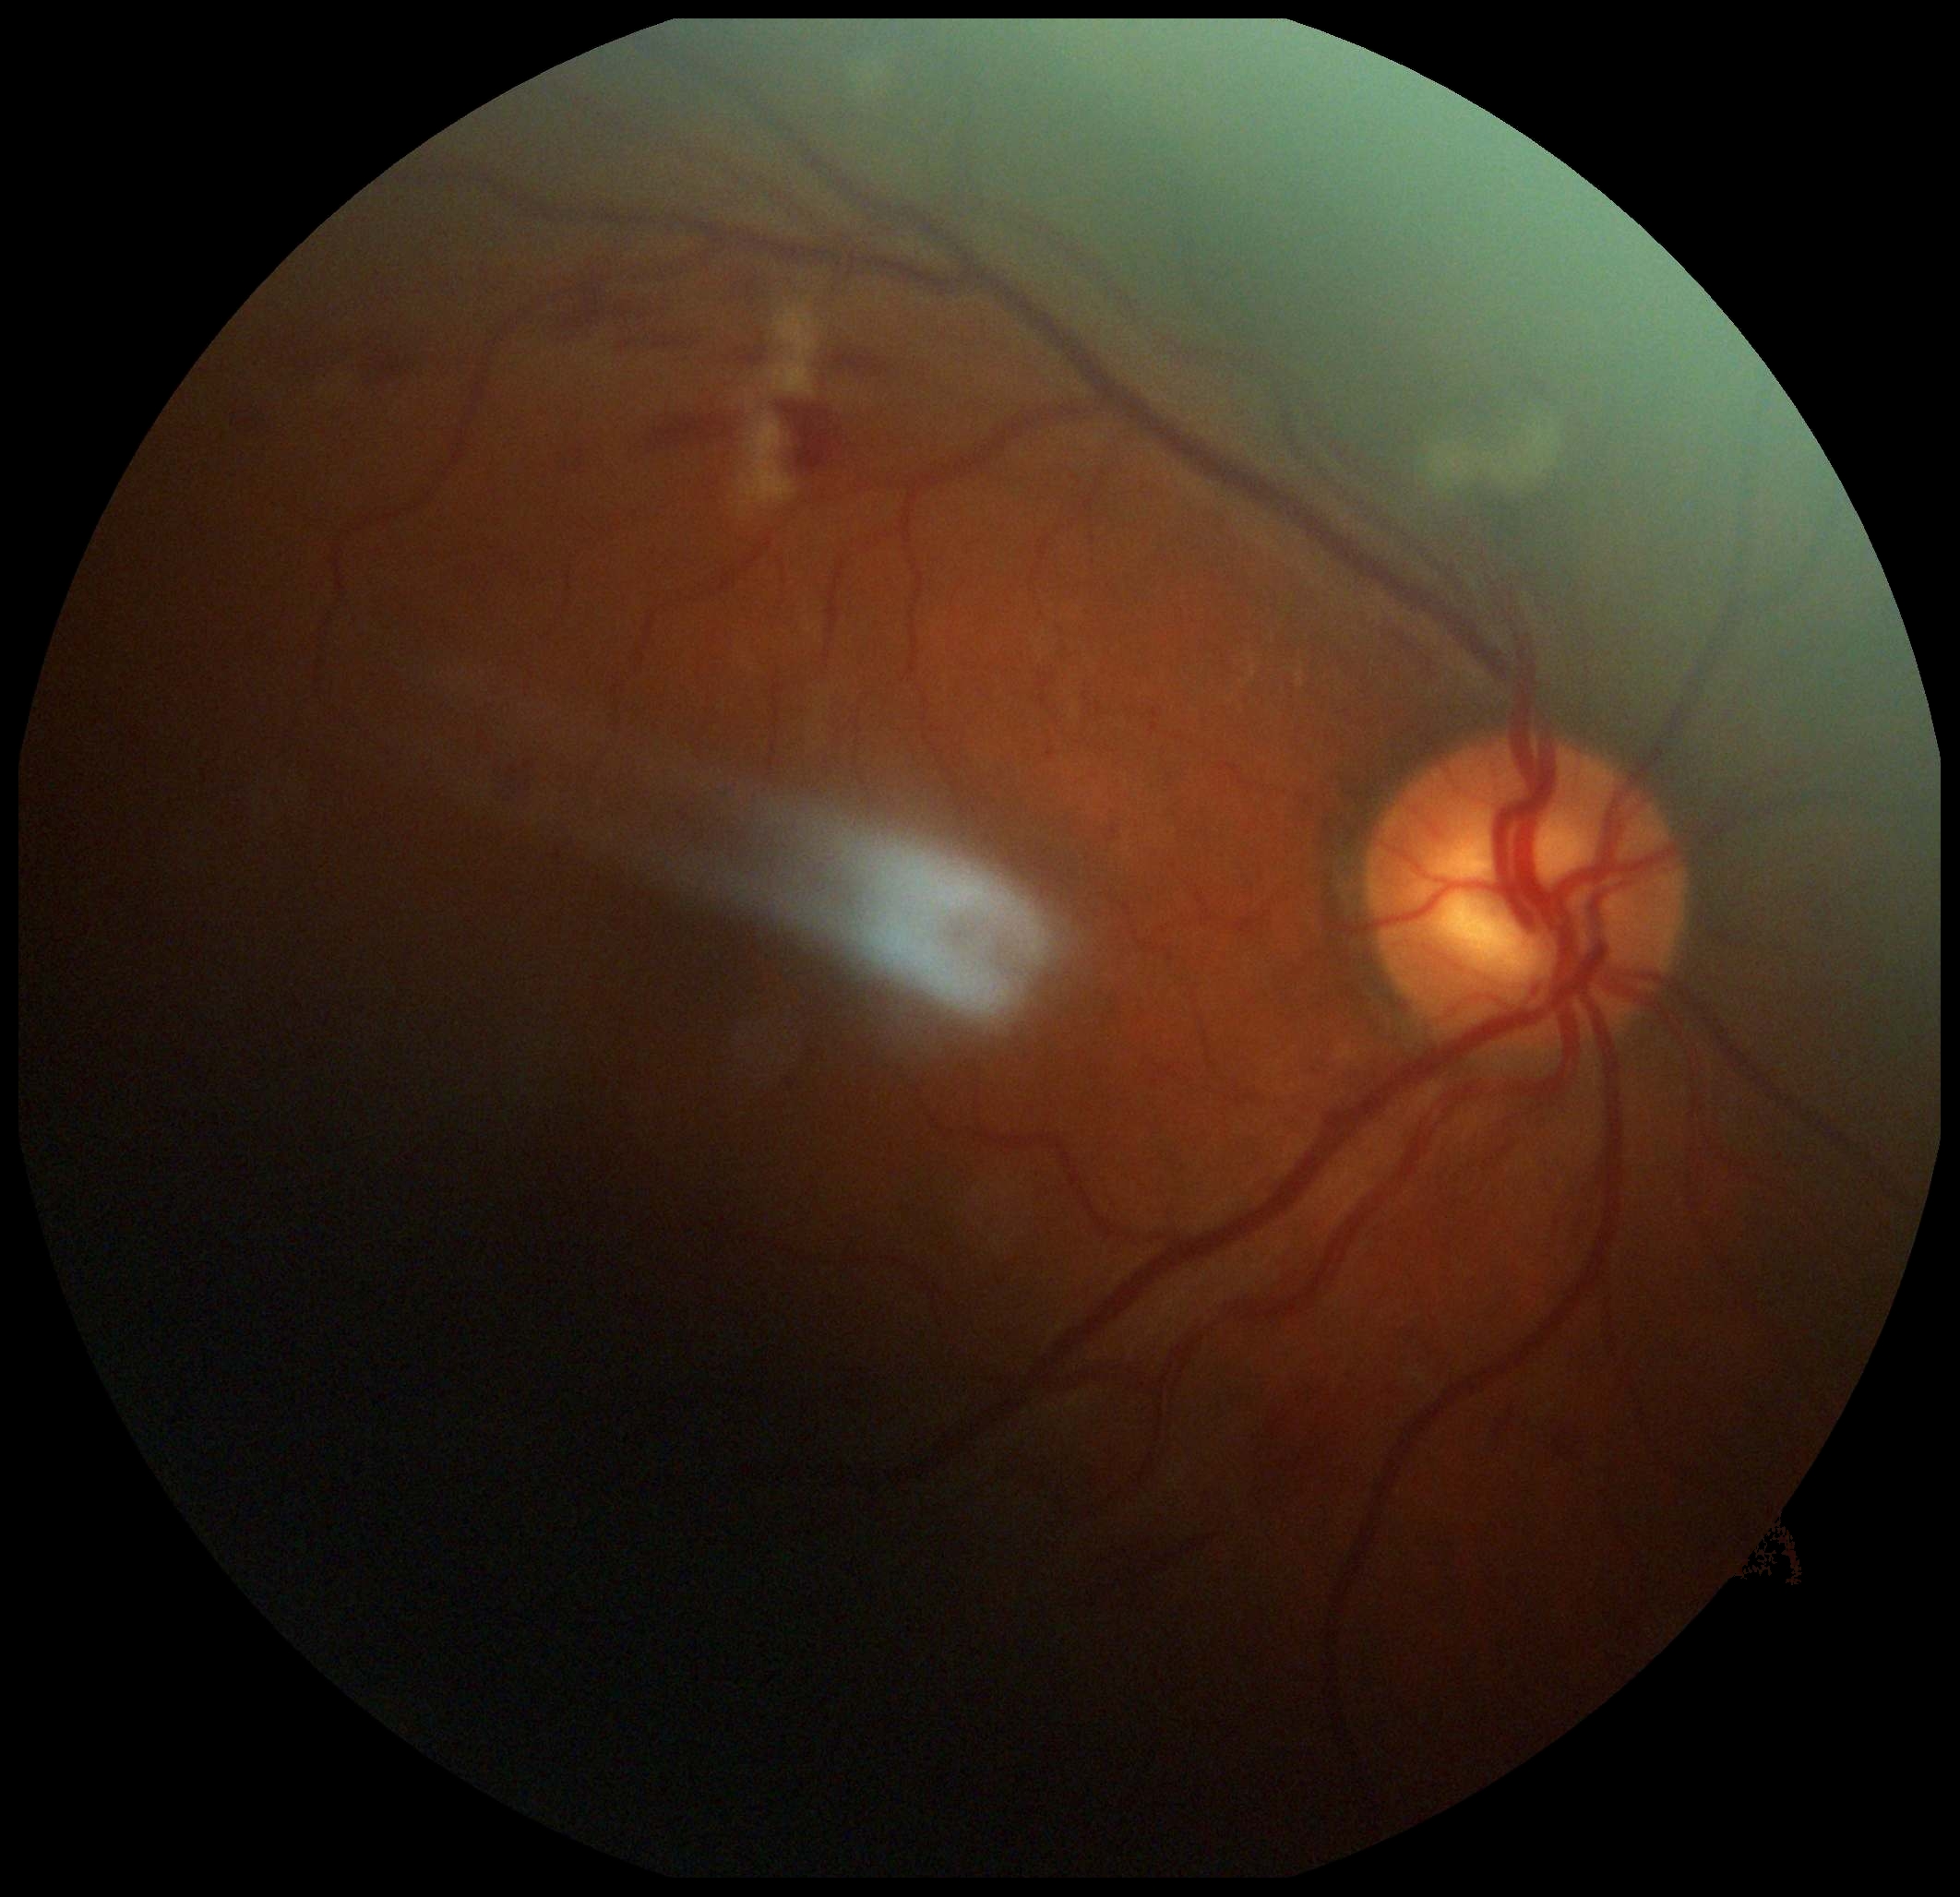
DR stage: moderate non-proliferative diabetic retinopathy (grade 2) — more than just microaneurysms but less than severe NPDR.